Color fundus photograph.
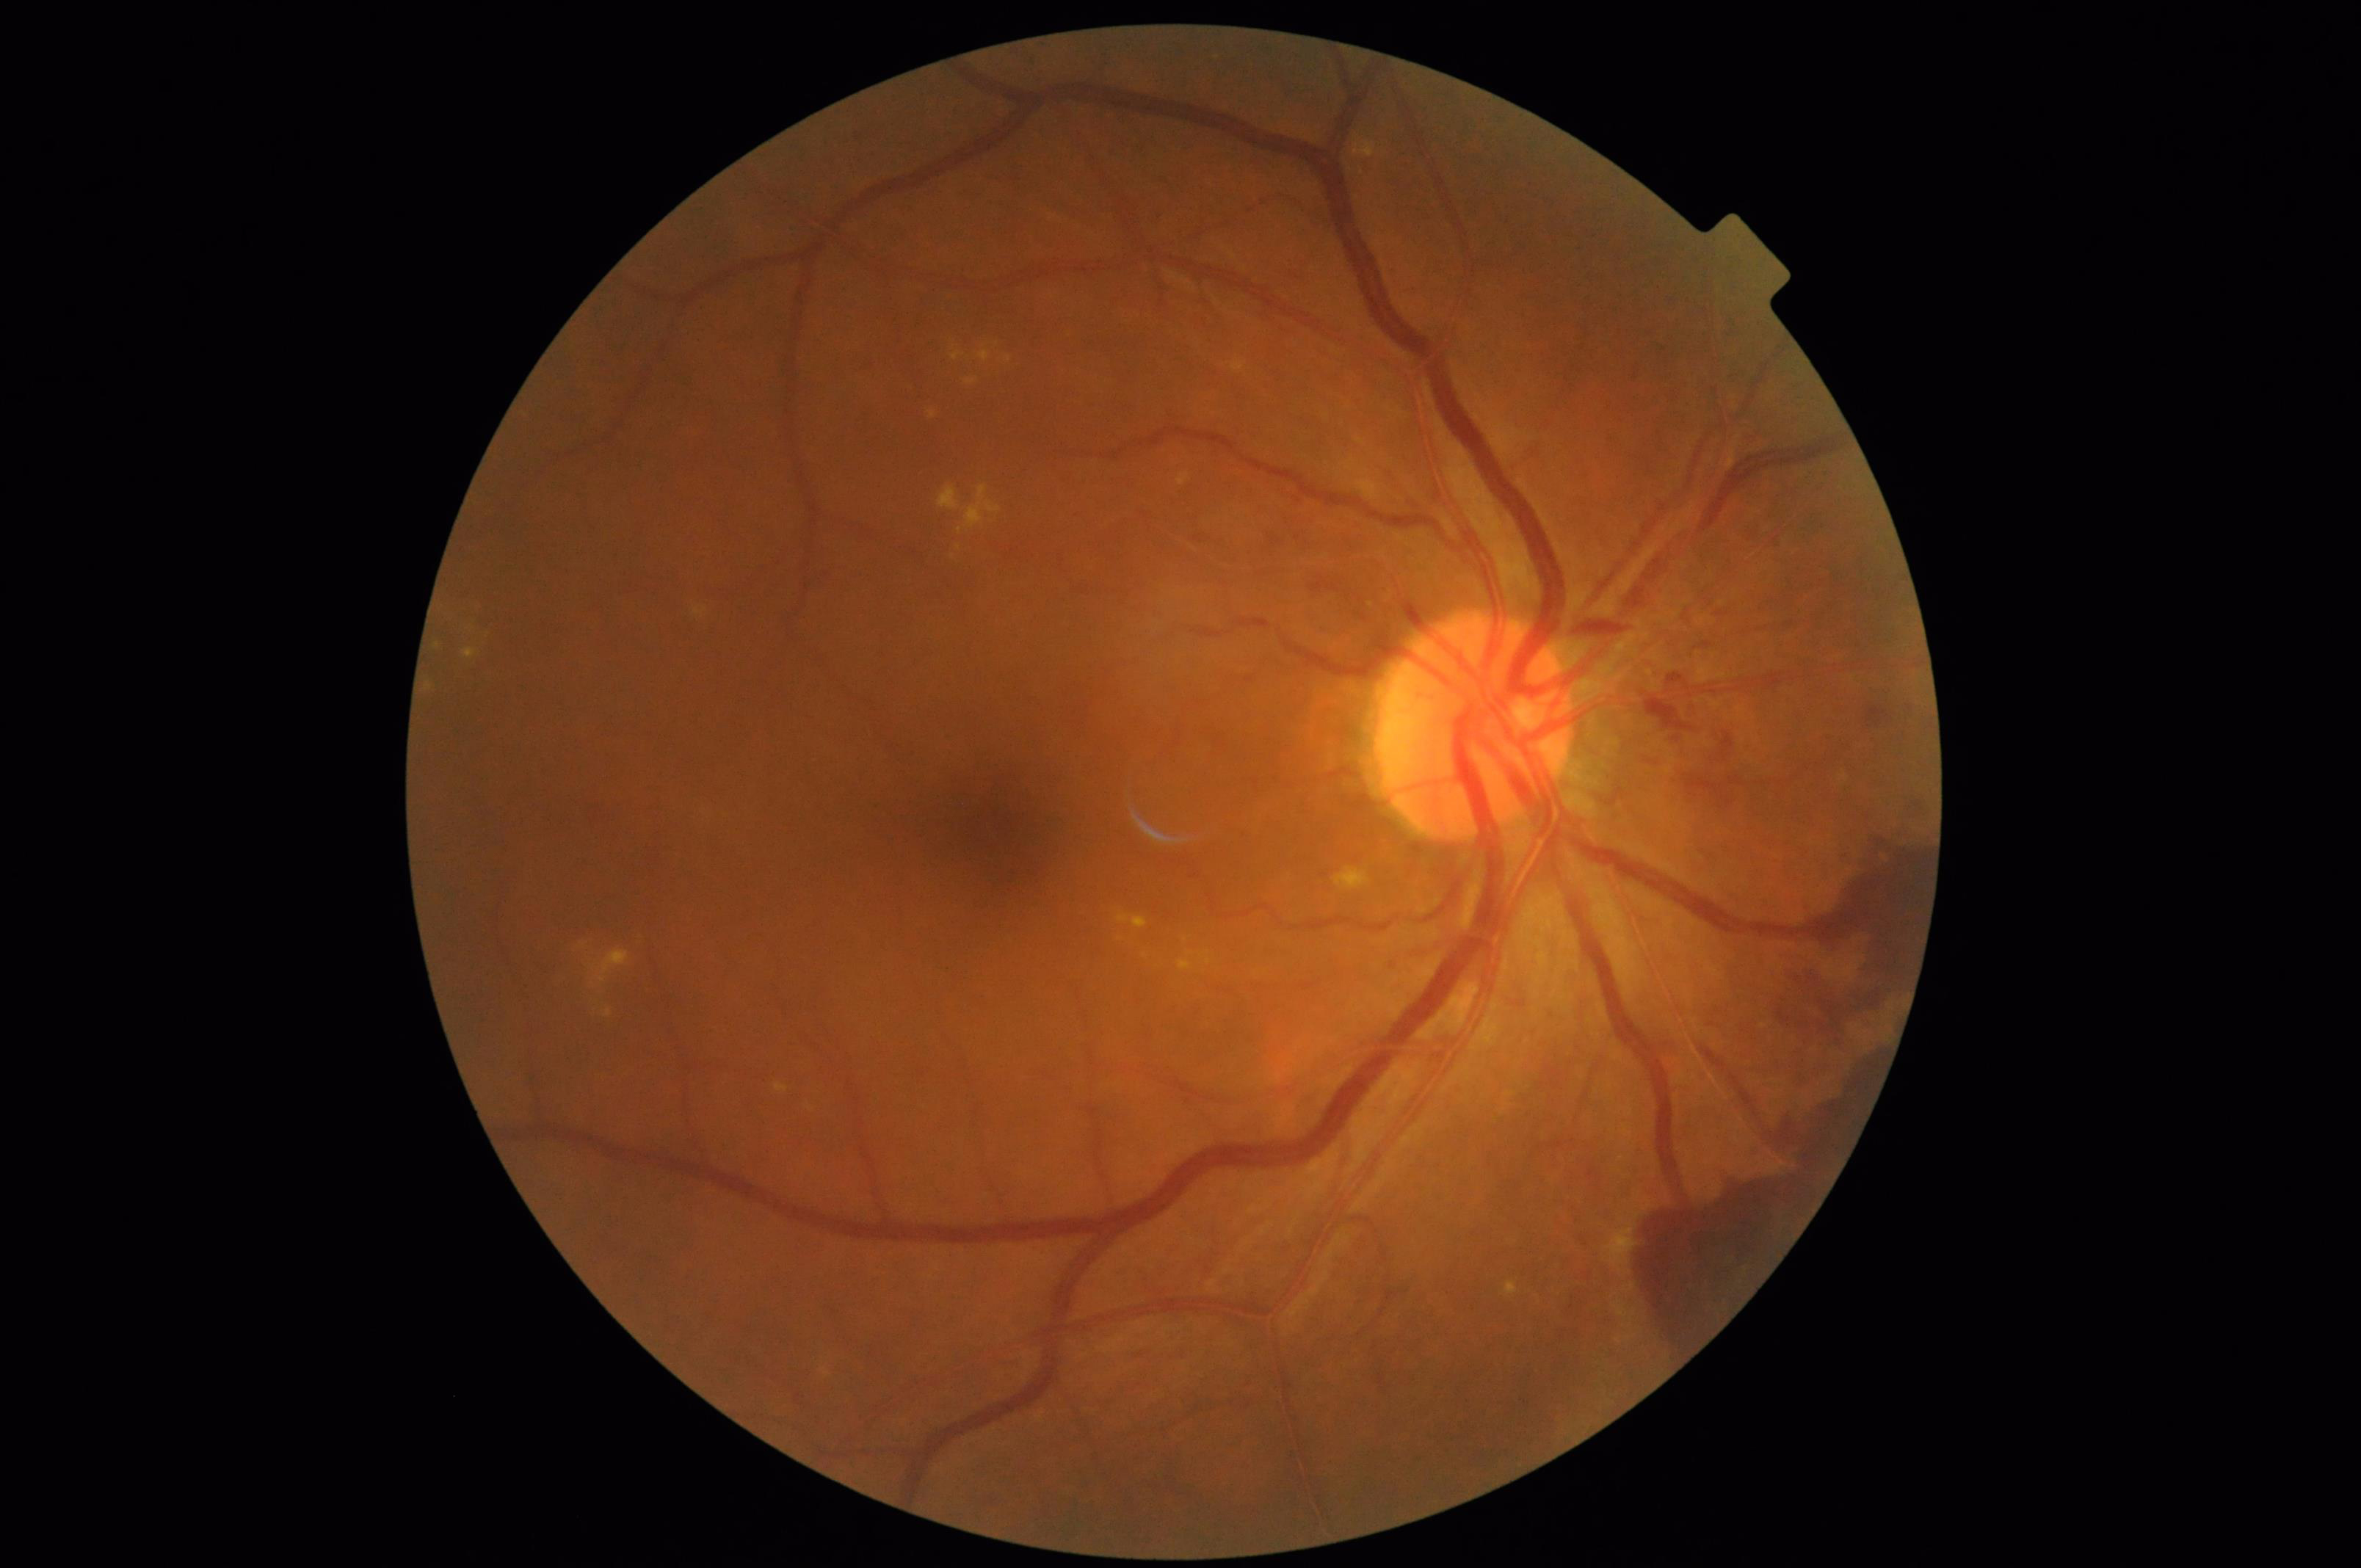 No noticeable blur. Image quality is adequate for diagnostic use. No over- or under-exposure. Good dynamic range.